DR severity per modified Davis staging
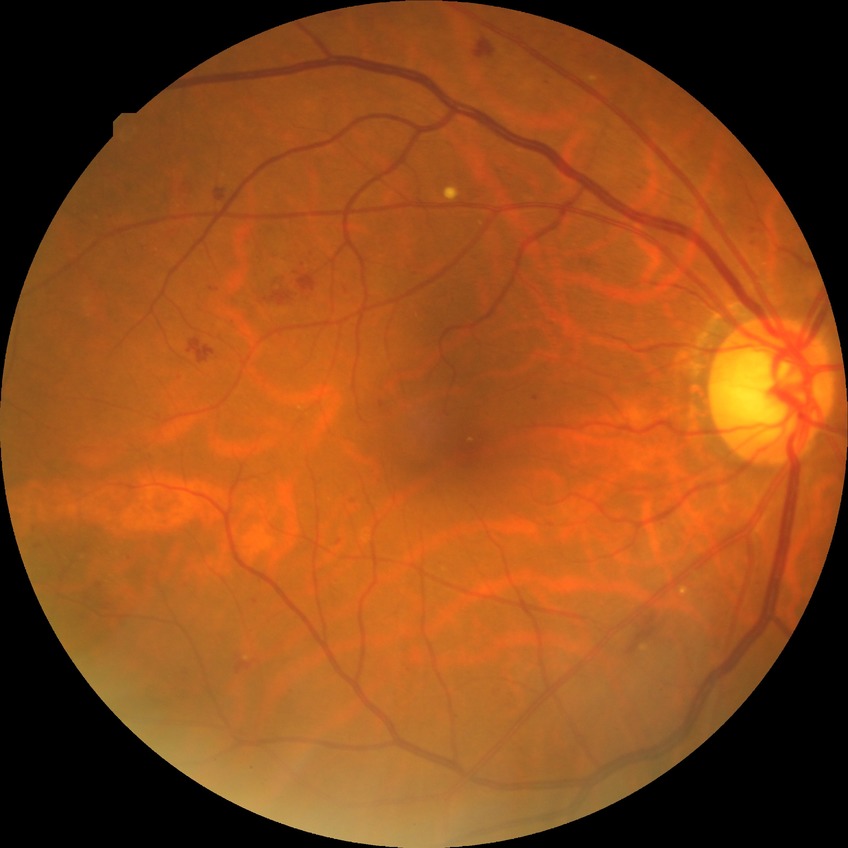
Diabetic retinopathy (DR): proliferative diabetic retinopathy (PDR).